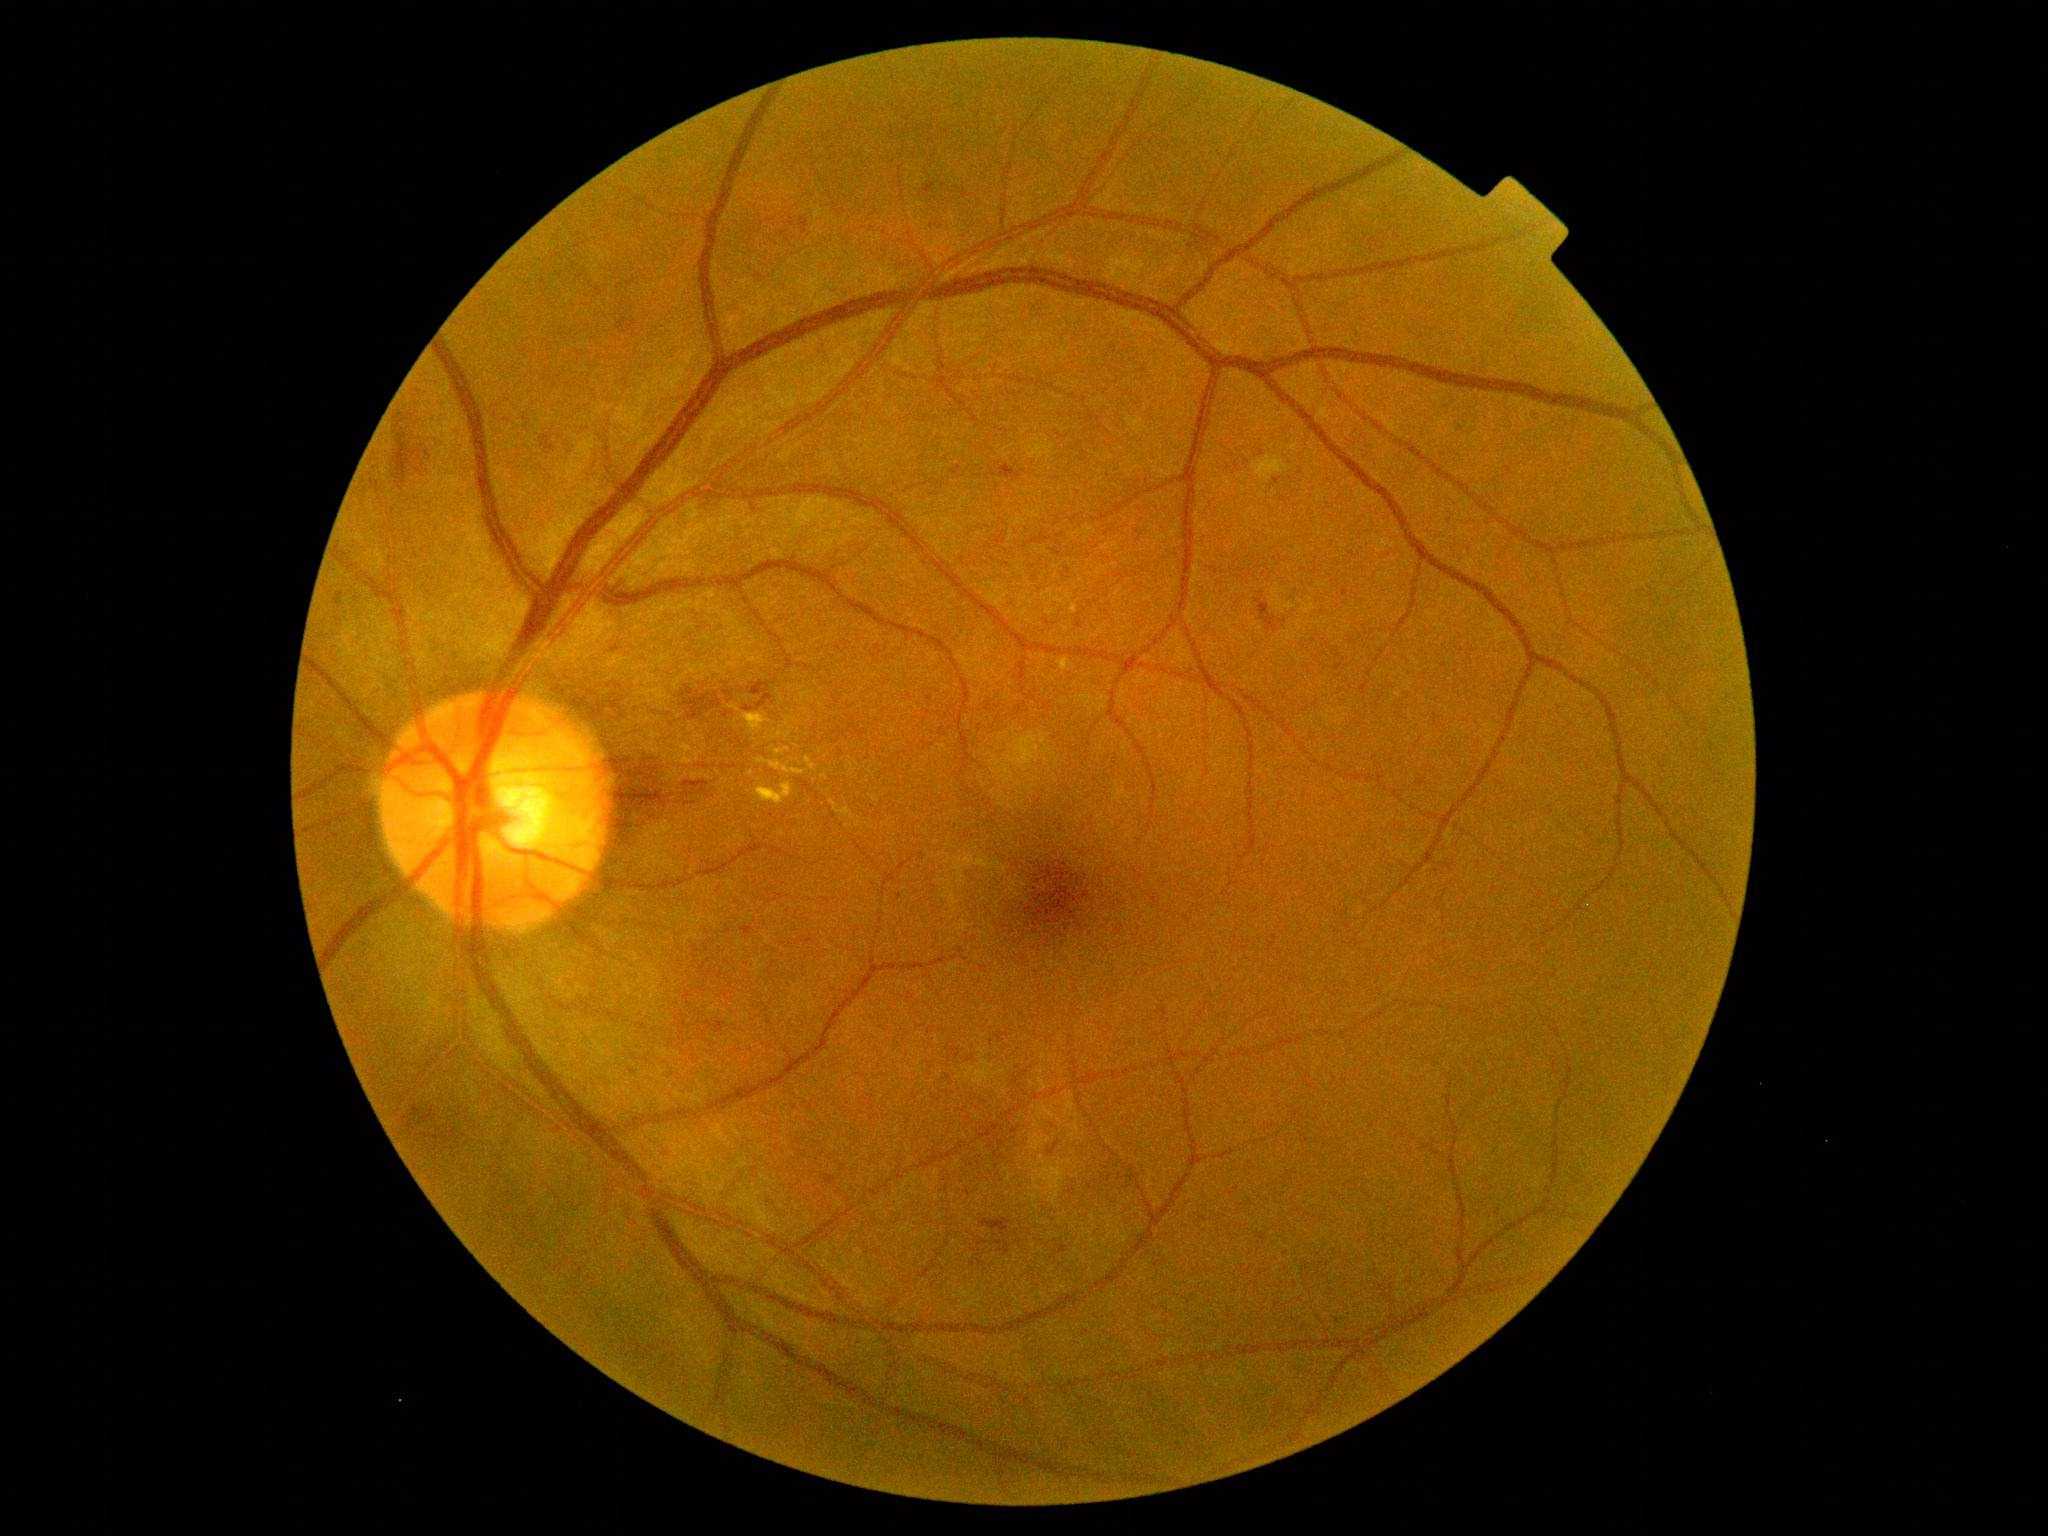 Diabetic retinopathy (DR) is 2 — more than just microaneurysms but less than severe NPDR.